100° field of view (Phoenix ICON) · image size 1240x1240 · wide-field fundus photograph of an infant.
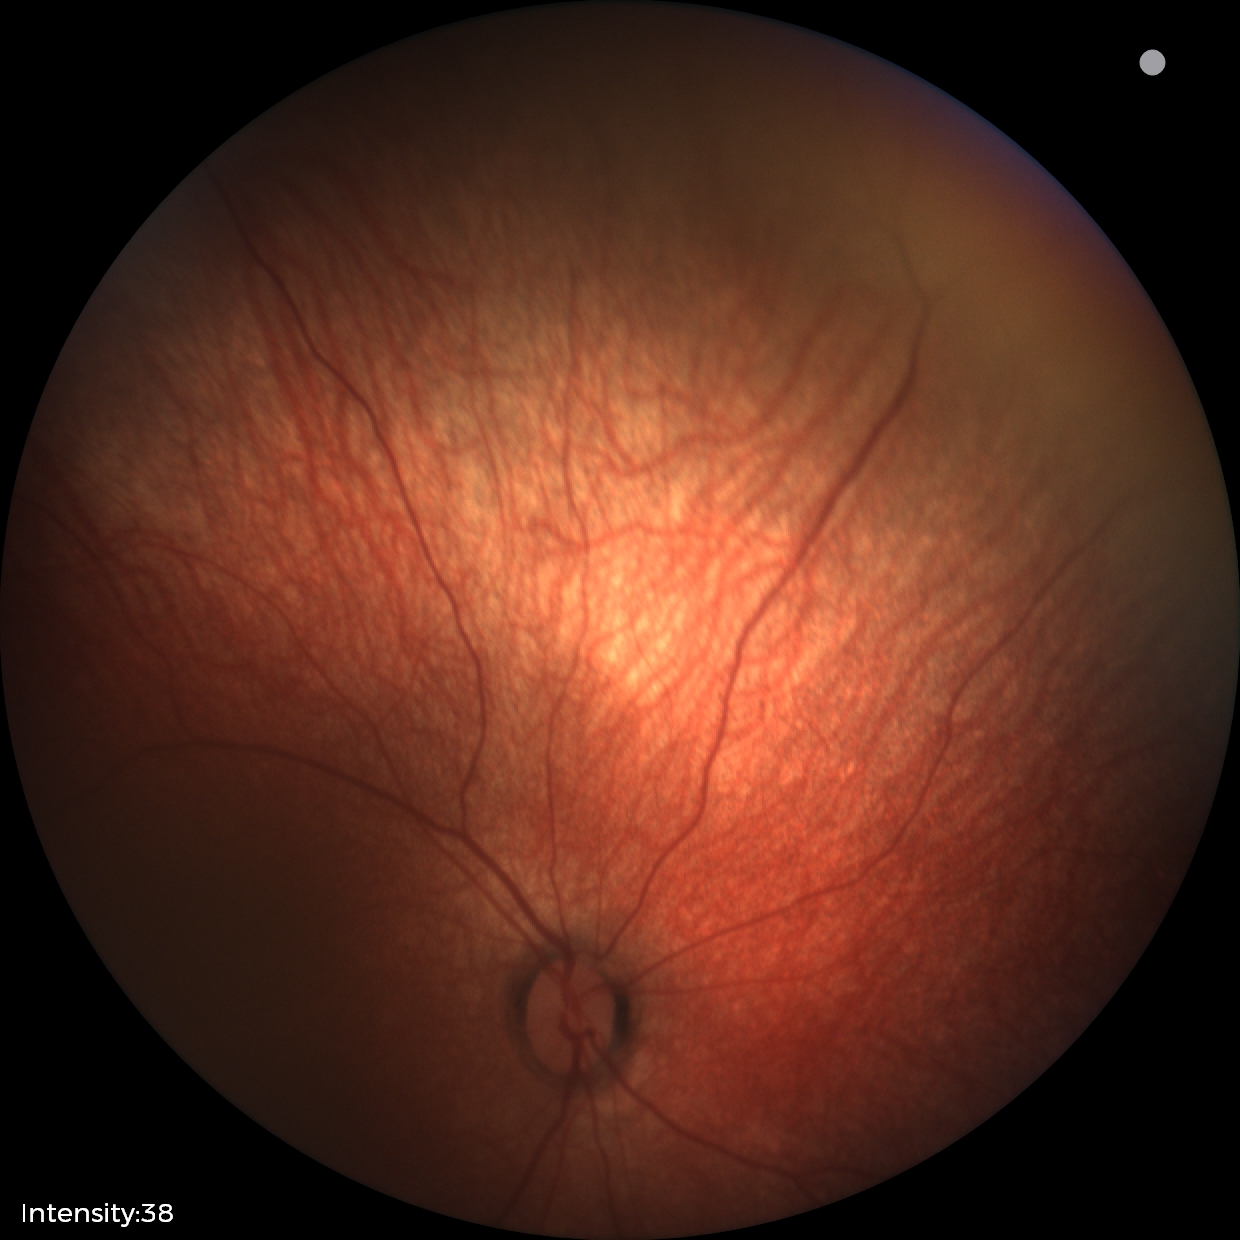

No retinal pathology identified on screening.